45-degree field of view, 2352 x 1568 pixels, color fundus image
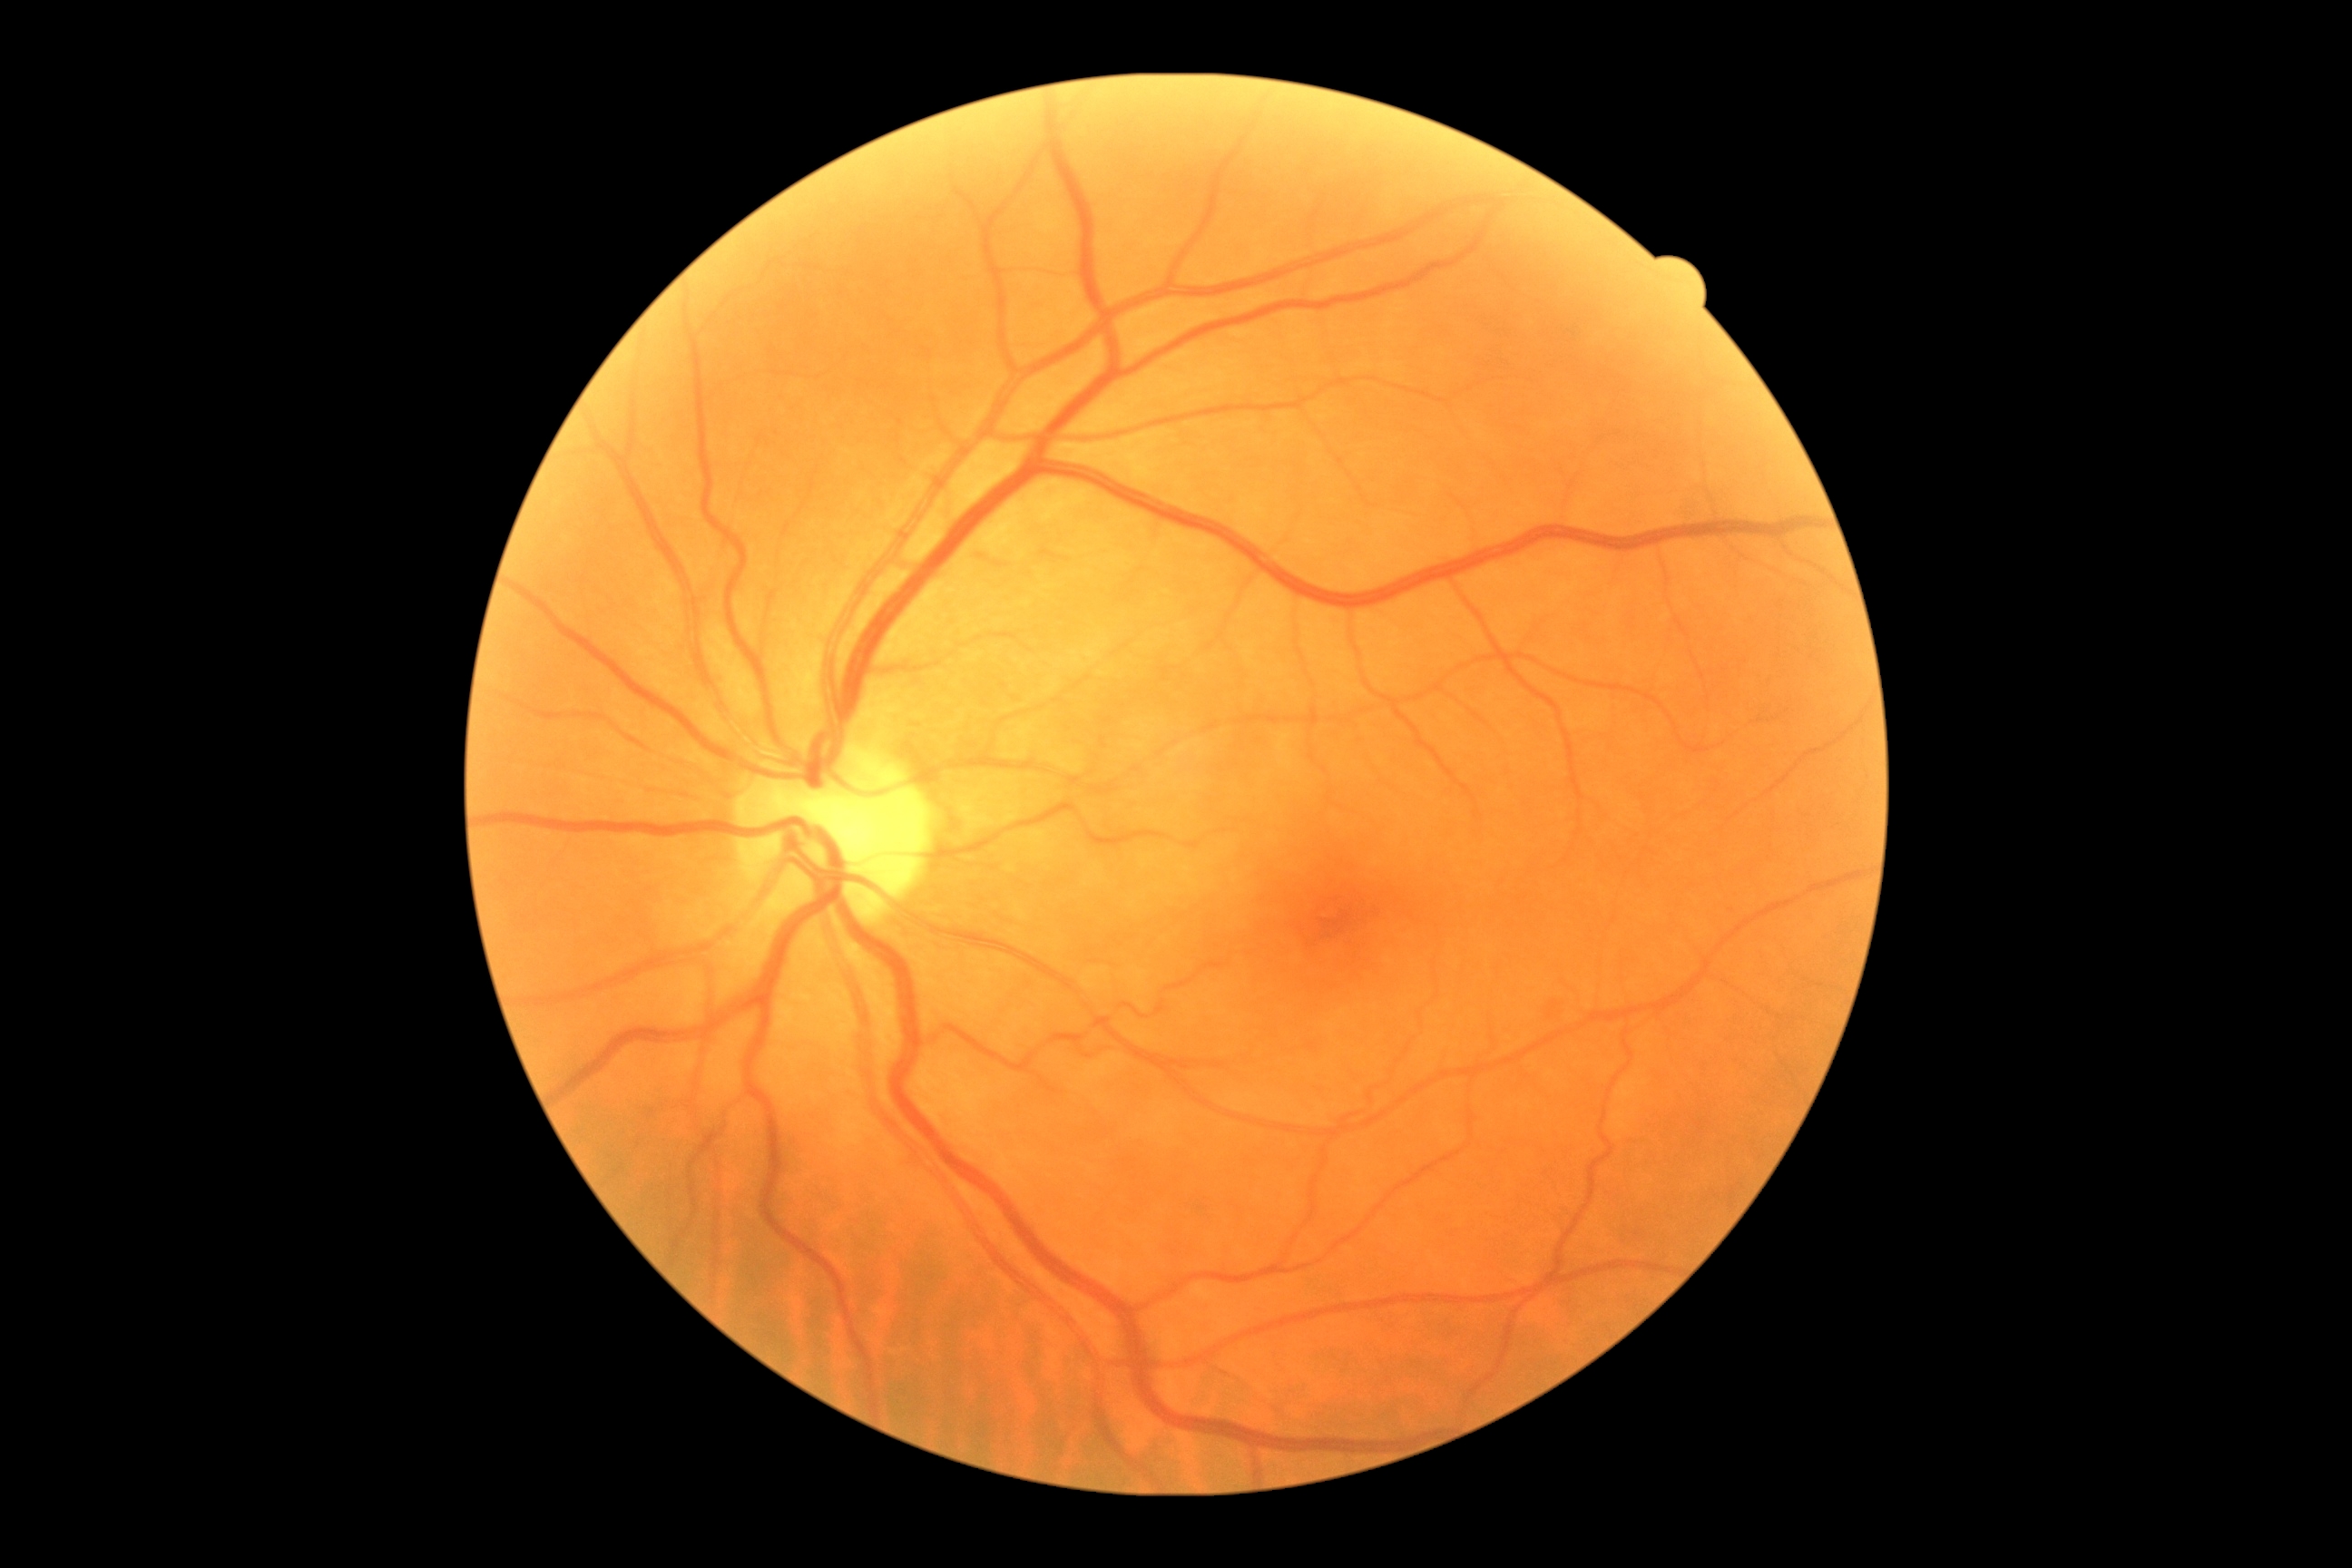 Diabetic retinopathy (DR): 1.
Disease class: non-proliferative diabetic retinopathy.